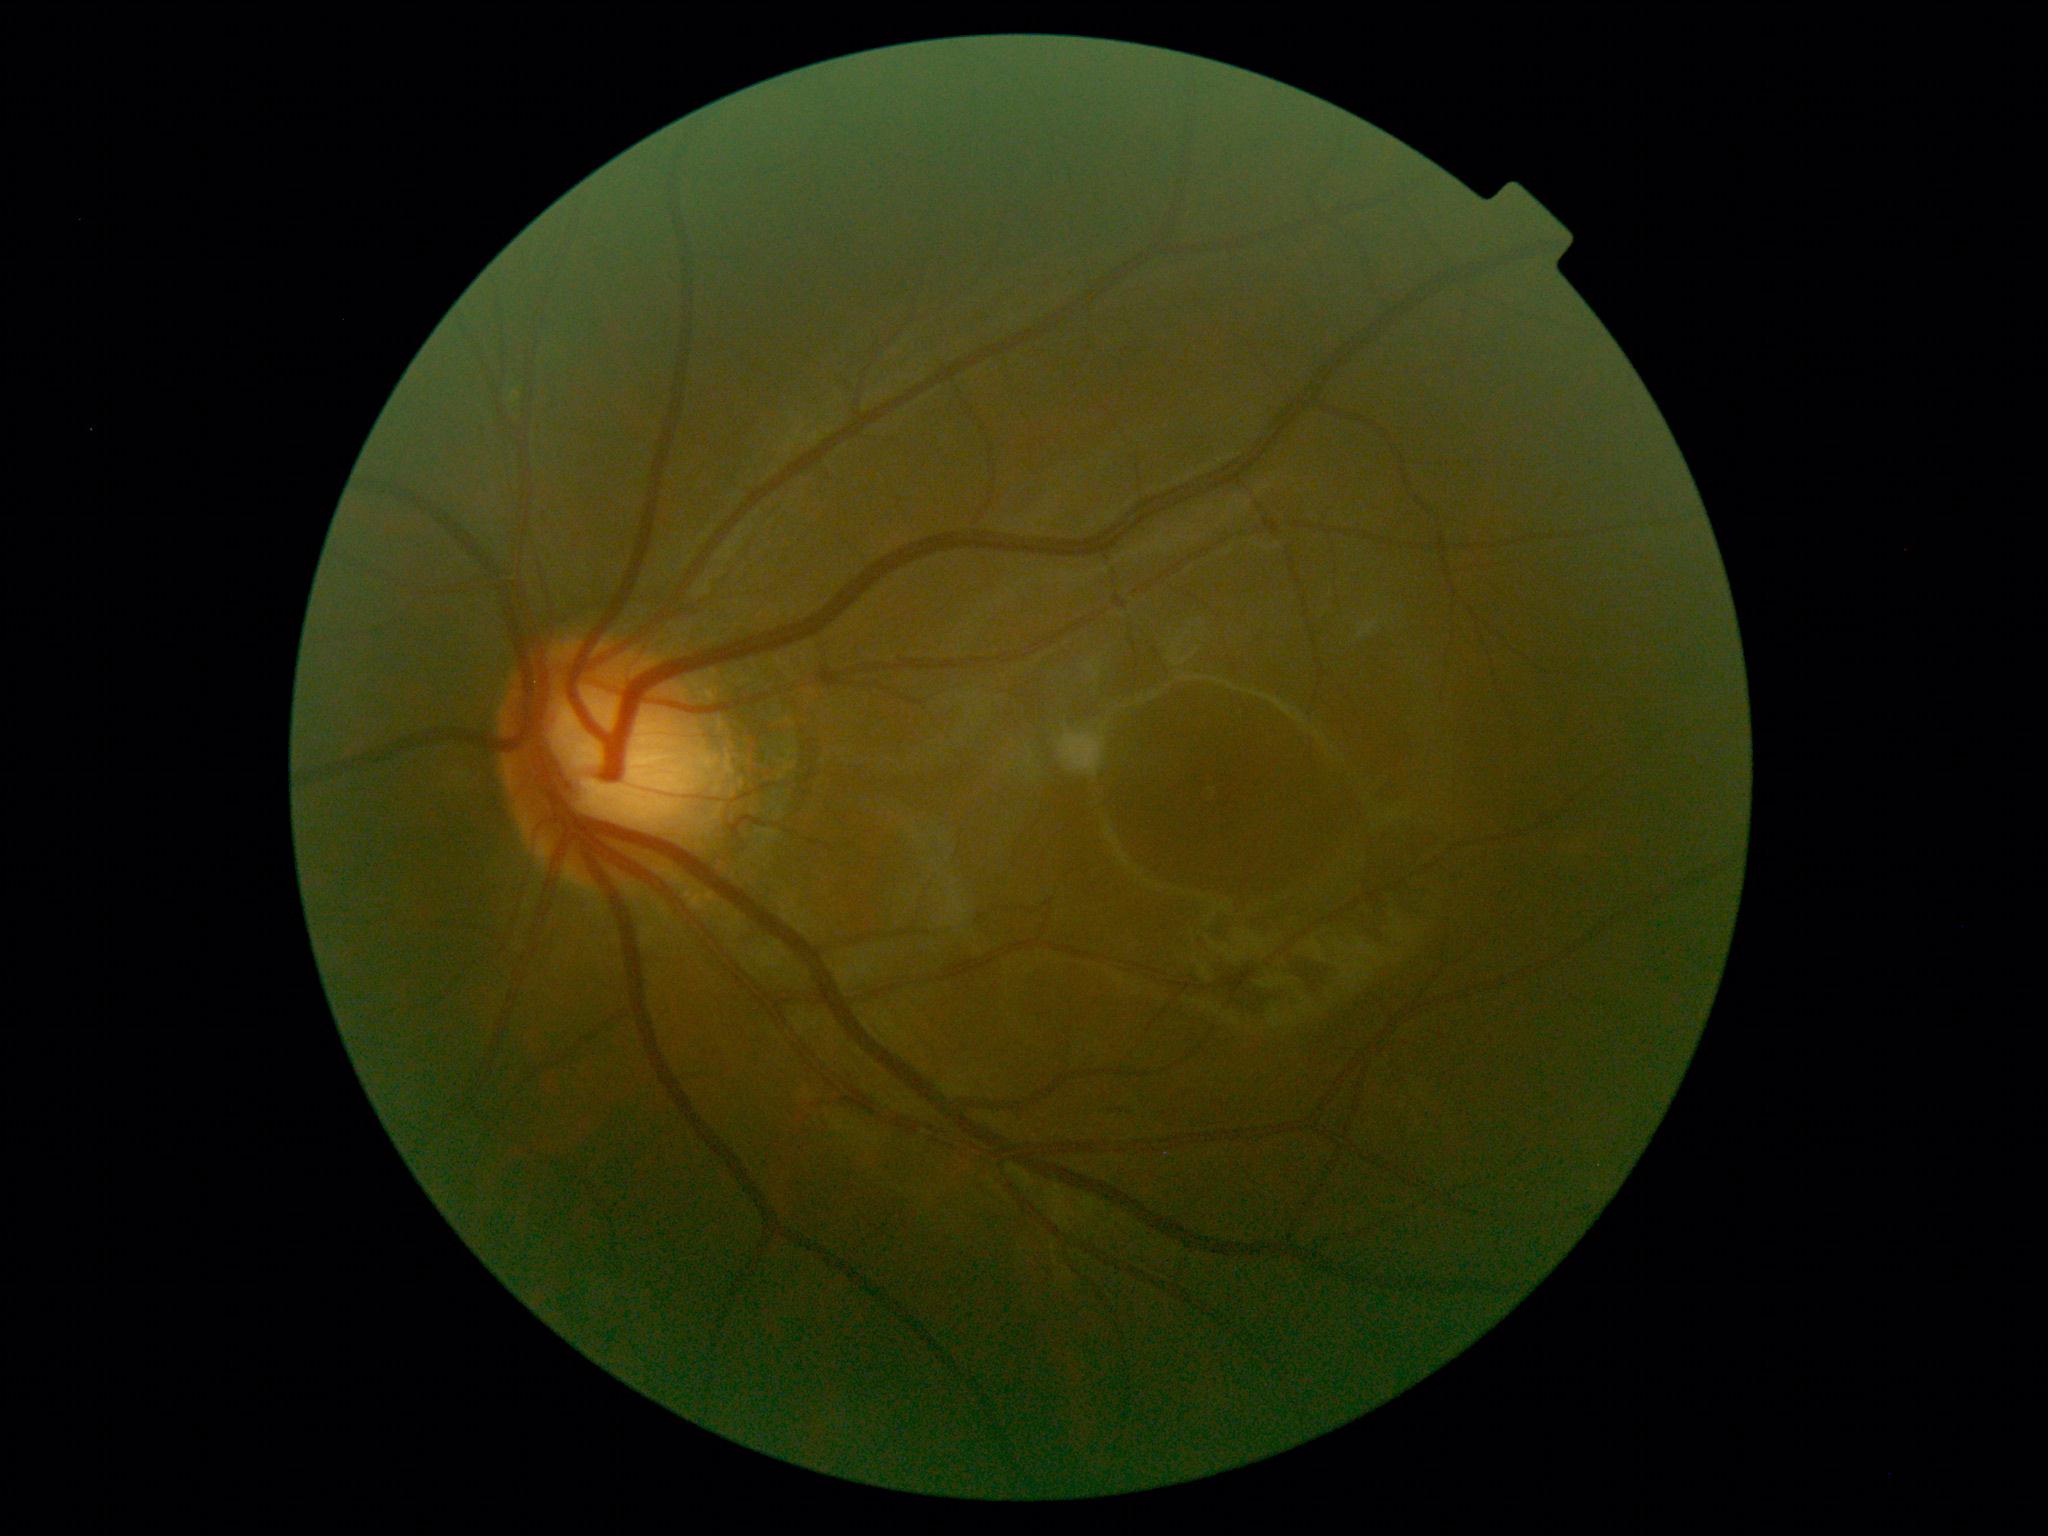

Diabetic retinopathy severity: 2/4.